848x848 · camera: NIDEK AFC-230 · 45° FOV
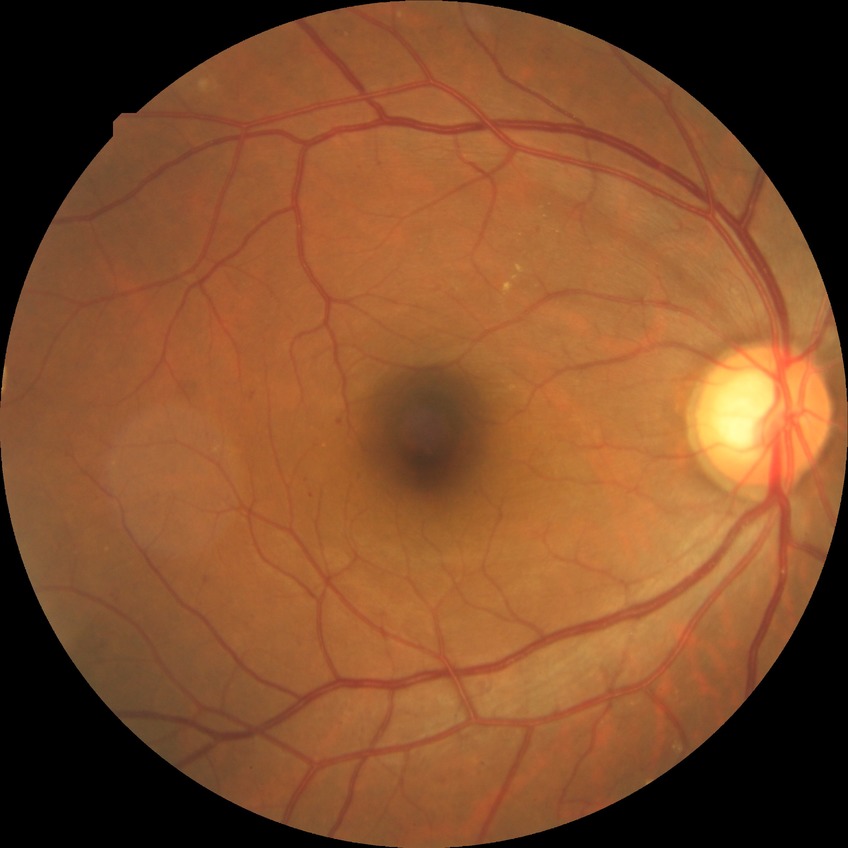

Modified Davis classification: simple diabetic retinopathy.